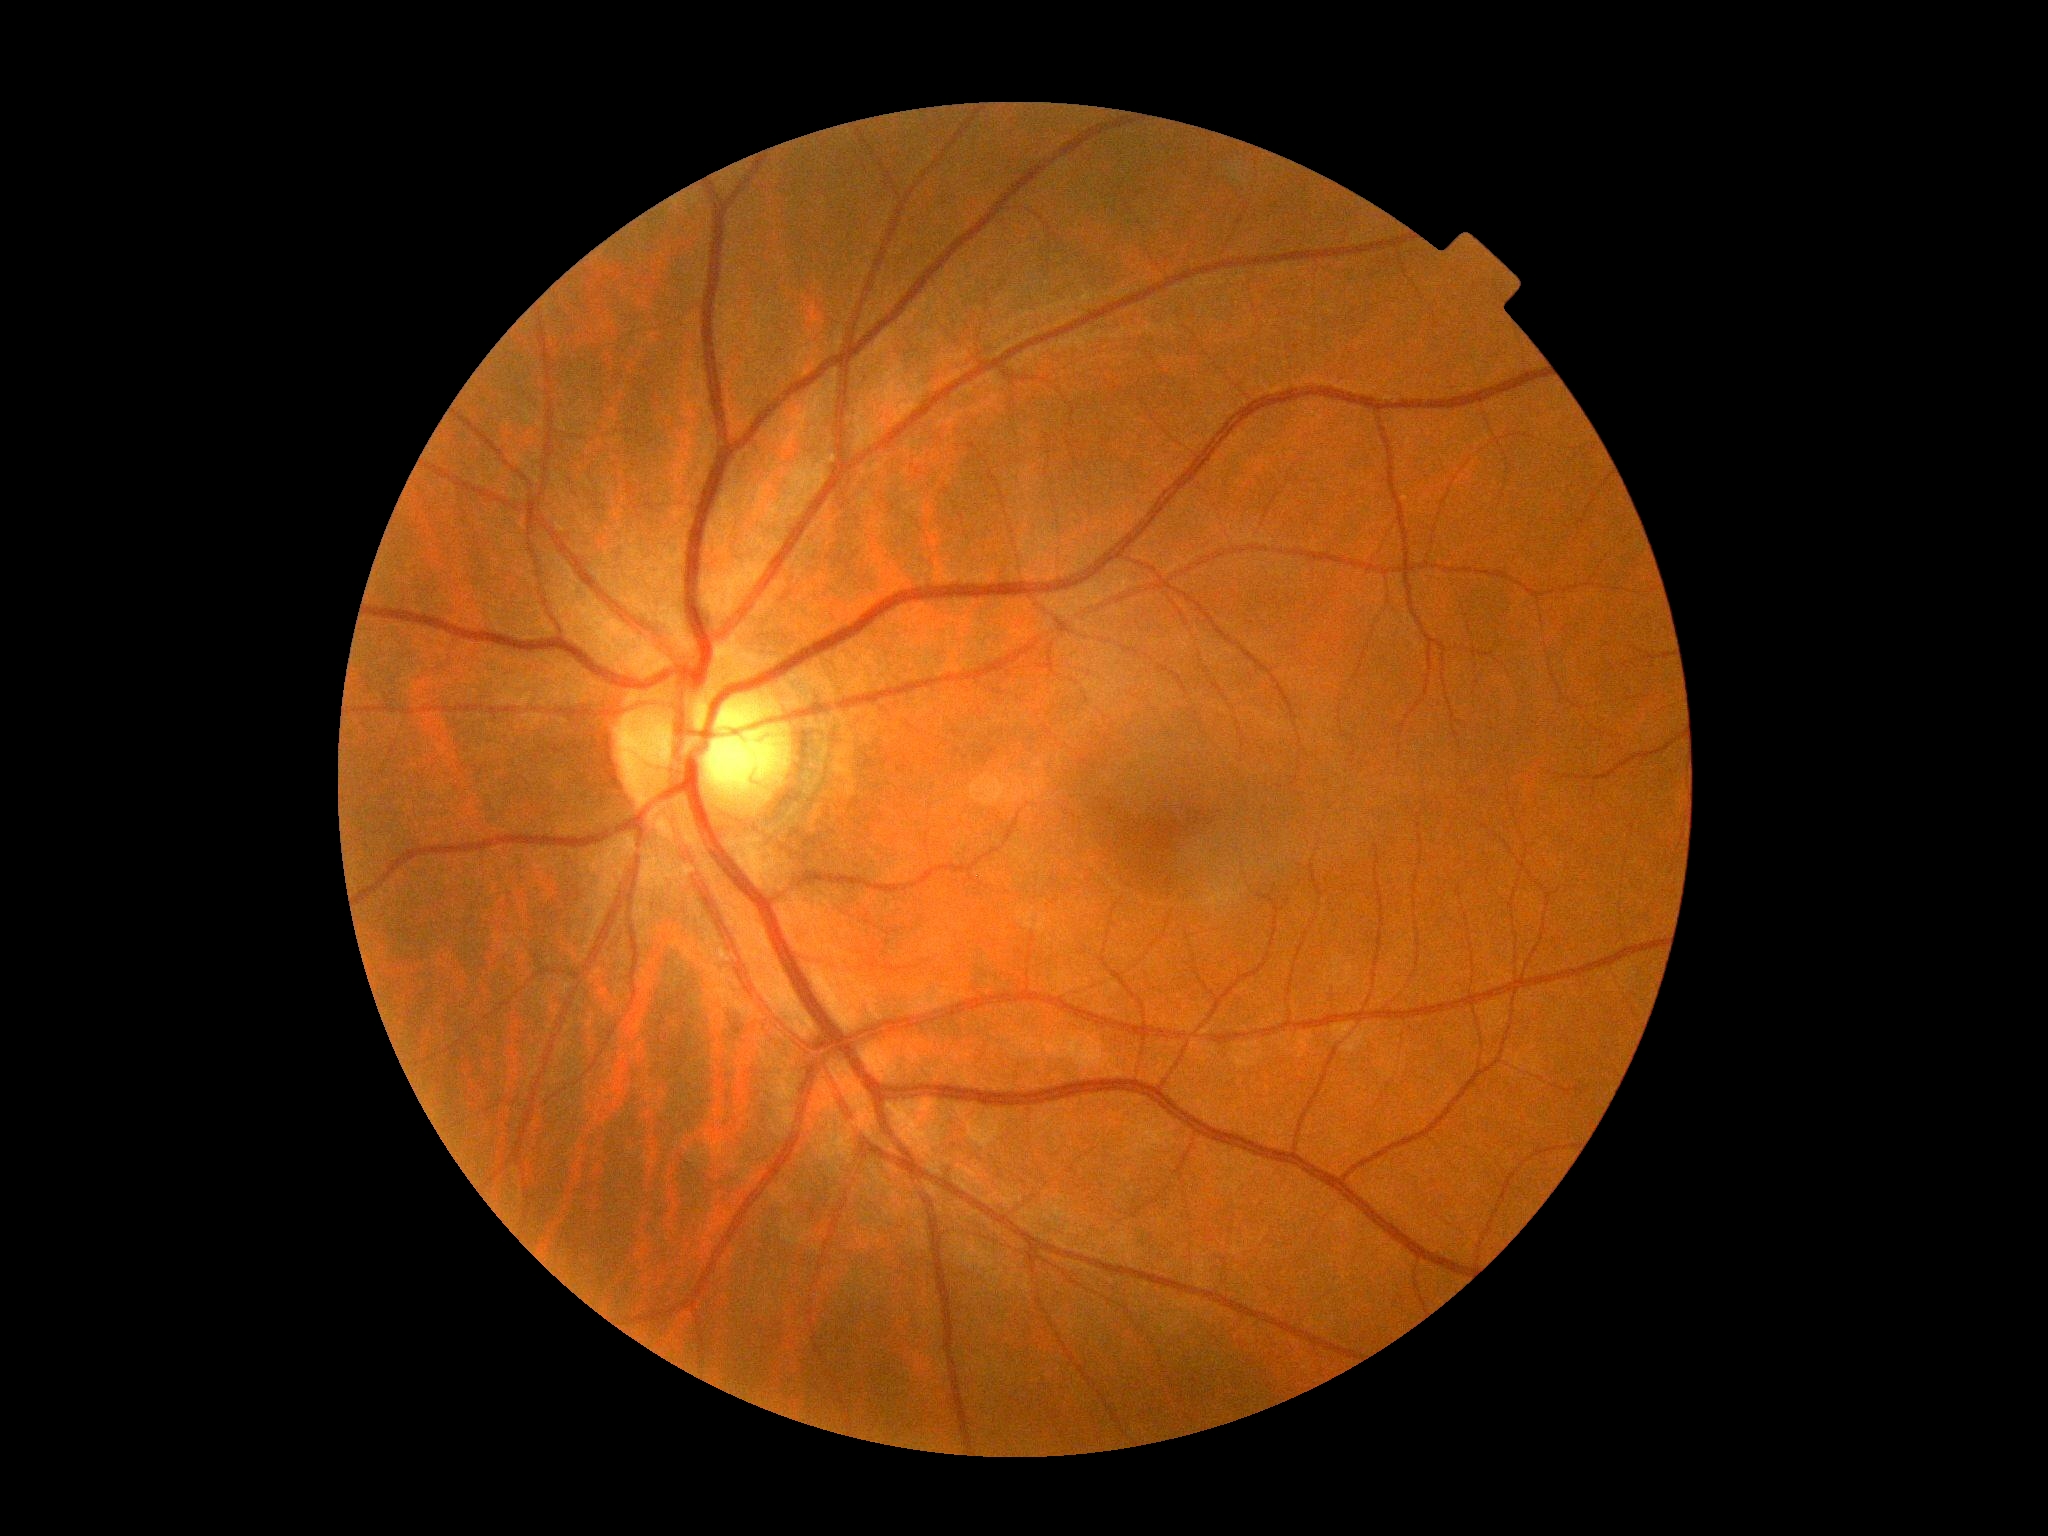 No diabetic retinal disease findings. DR is no apparent diabetic retinopathy (grade 0).